2212x1659
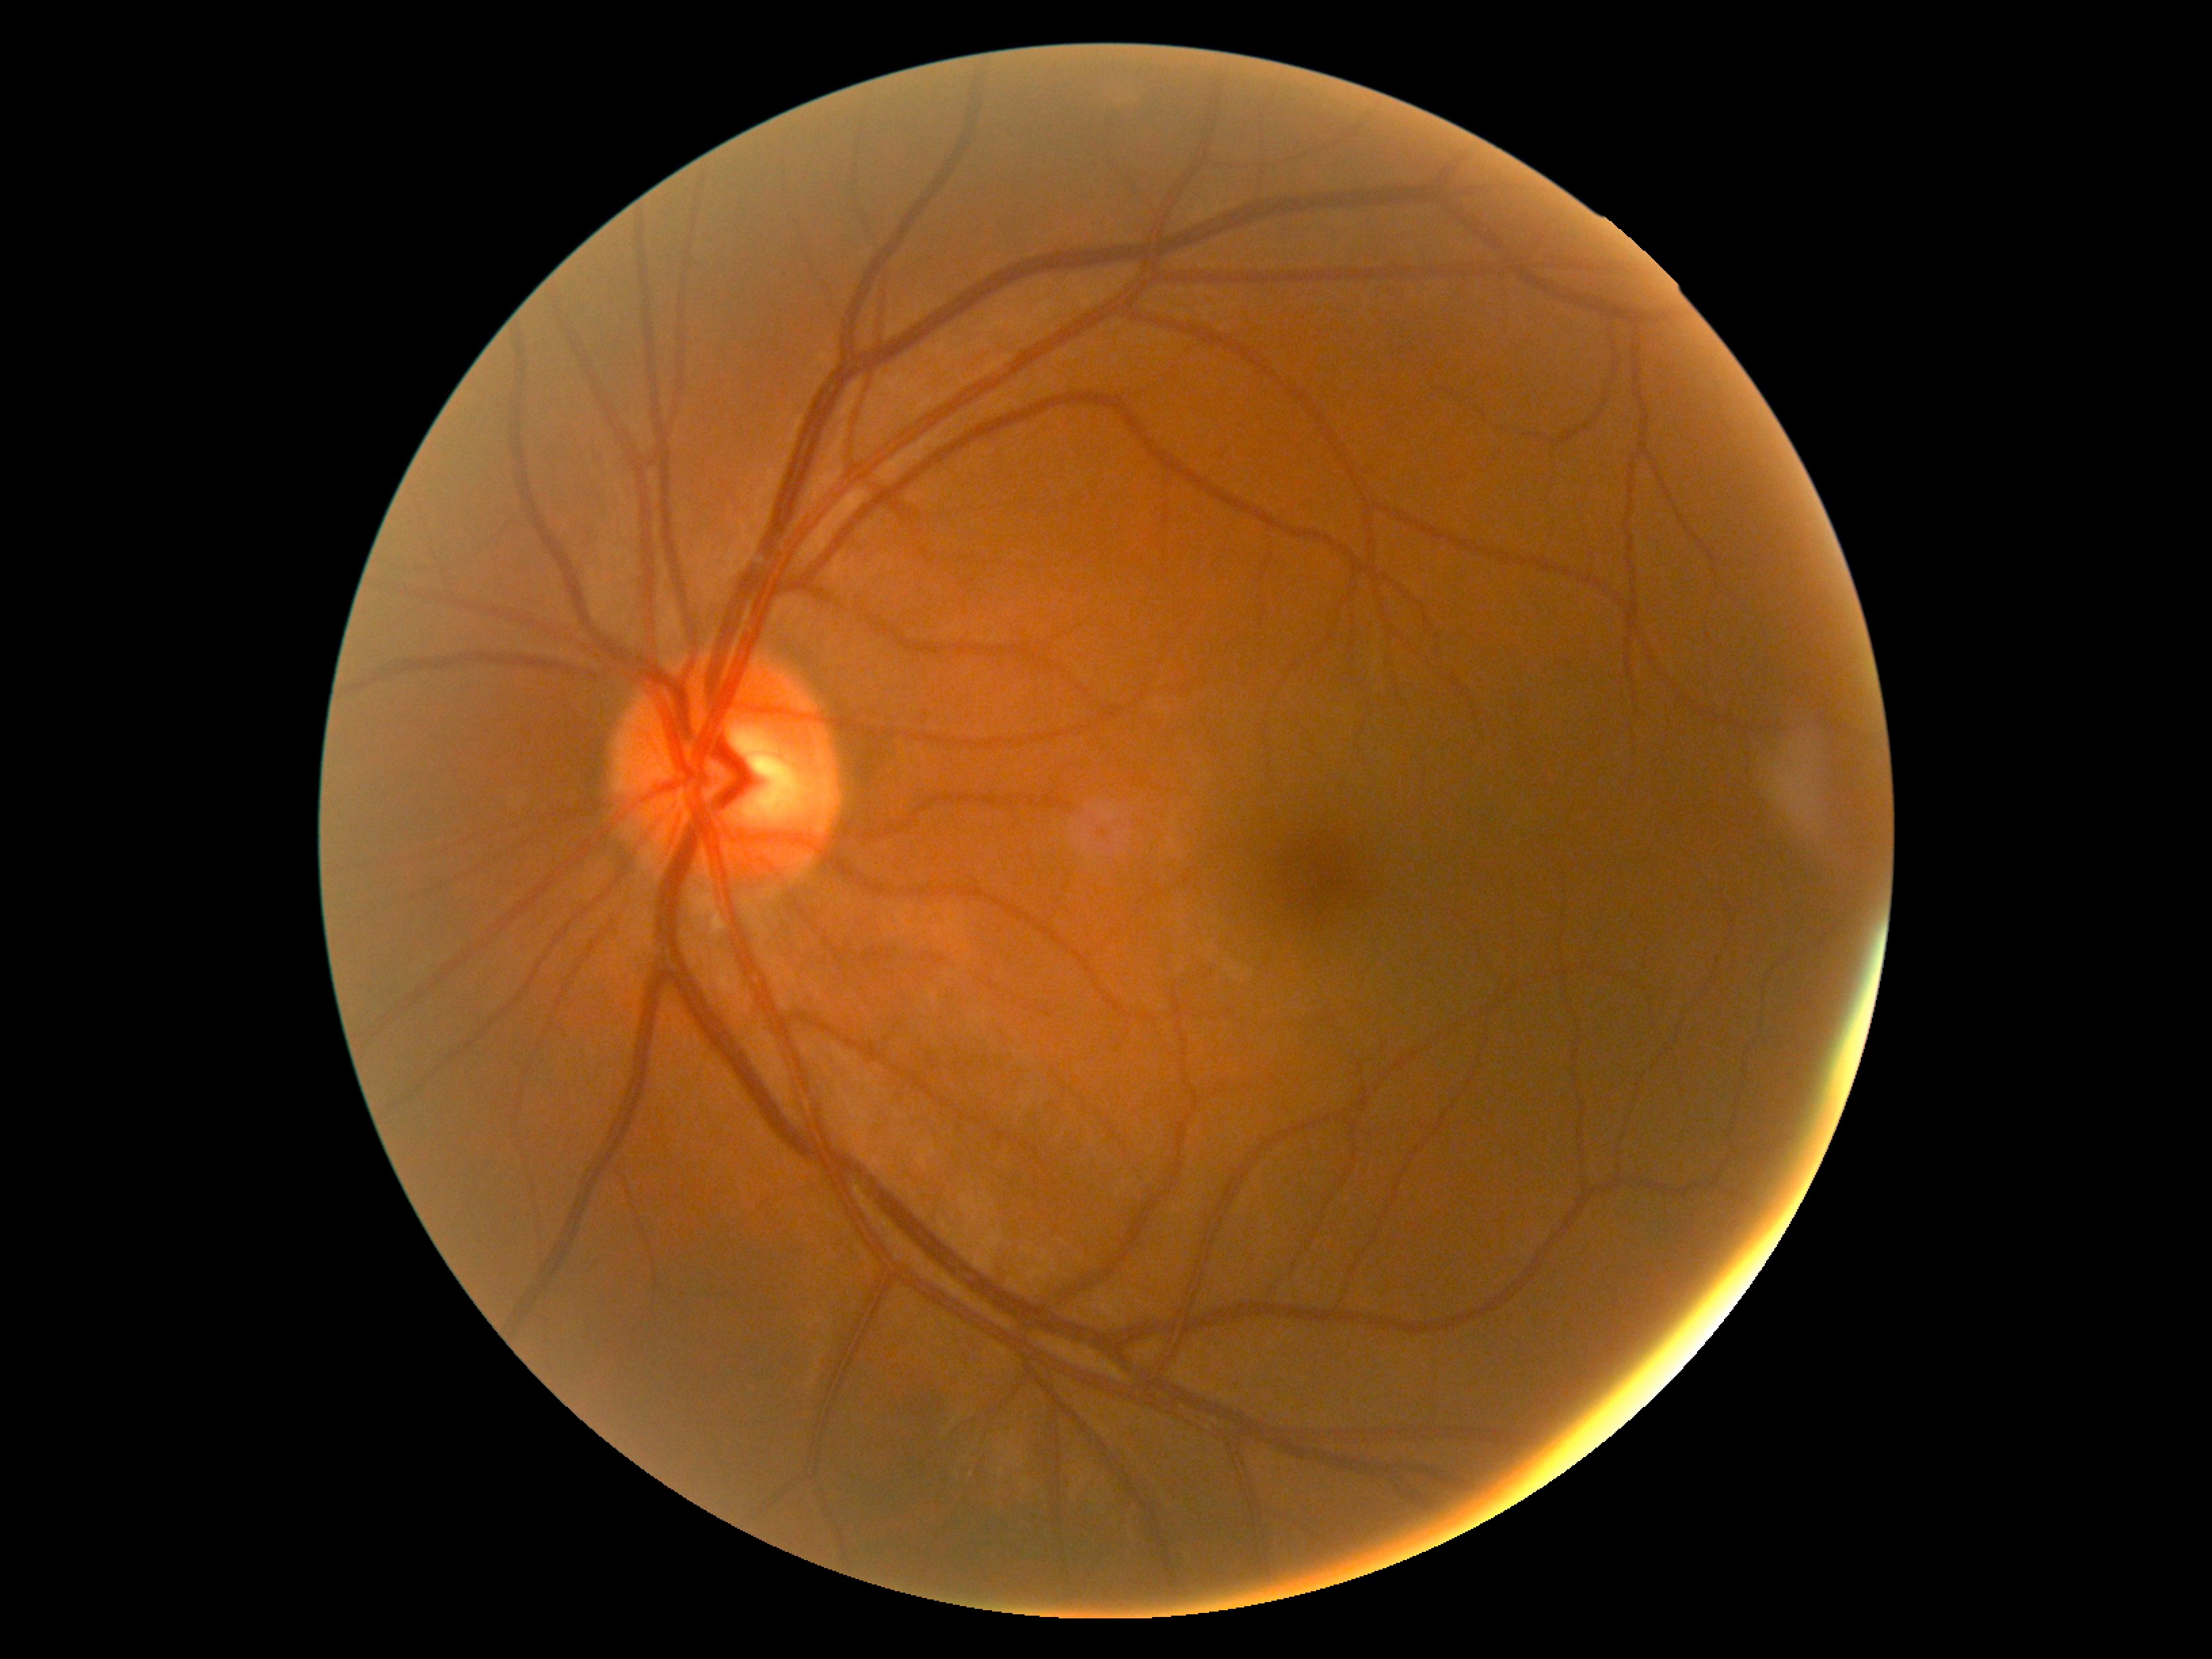 dr_grade: no apparent diabetic retinopathy (0) — no visible signs of diabetic retinopathy